Wide-field contact fundus photograph of an infant
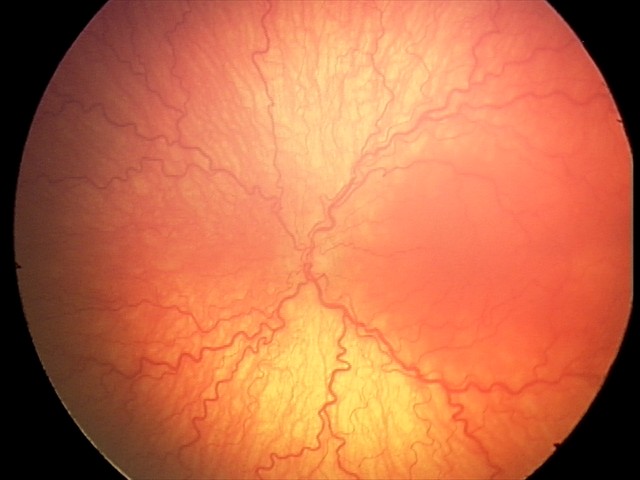
Examination diagnosed as aggressive ROP (A-ROP).